FOV: 45 degrees — 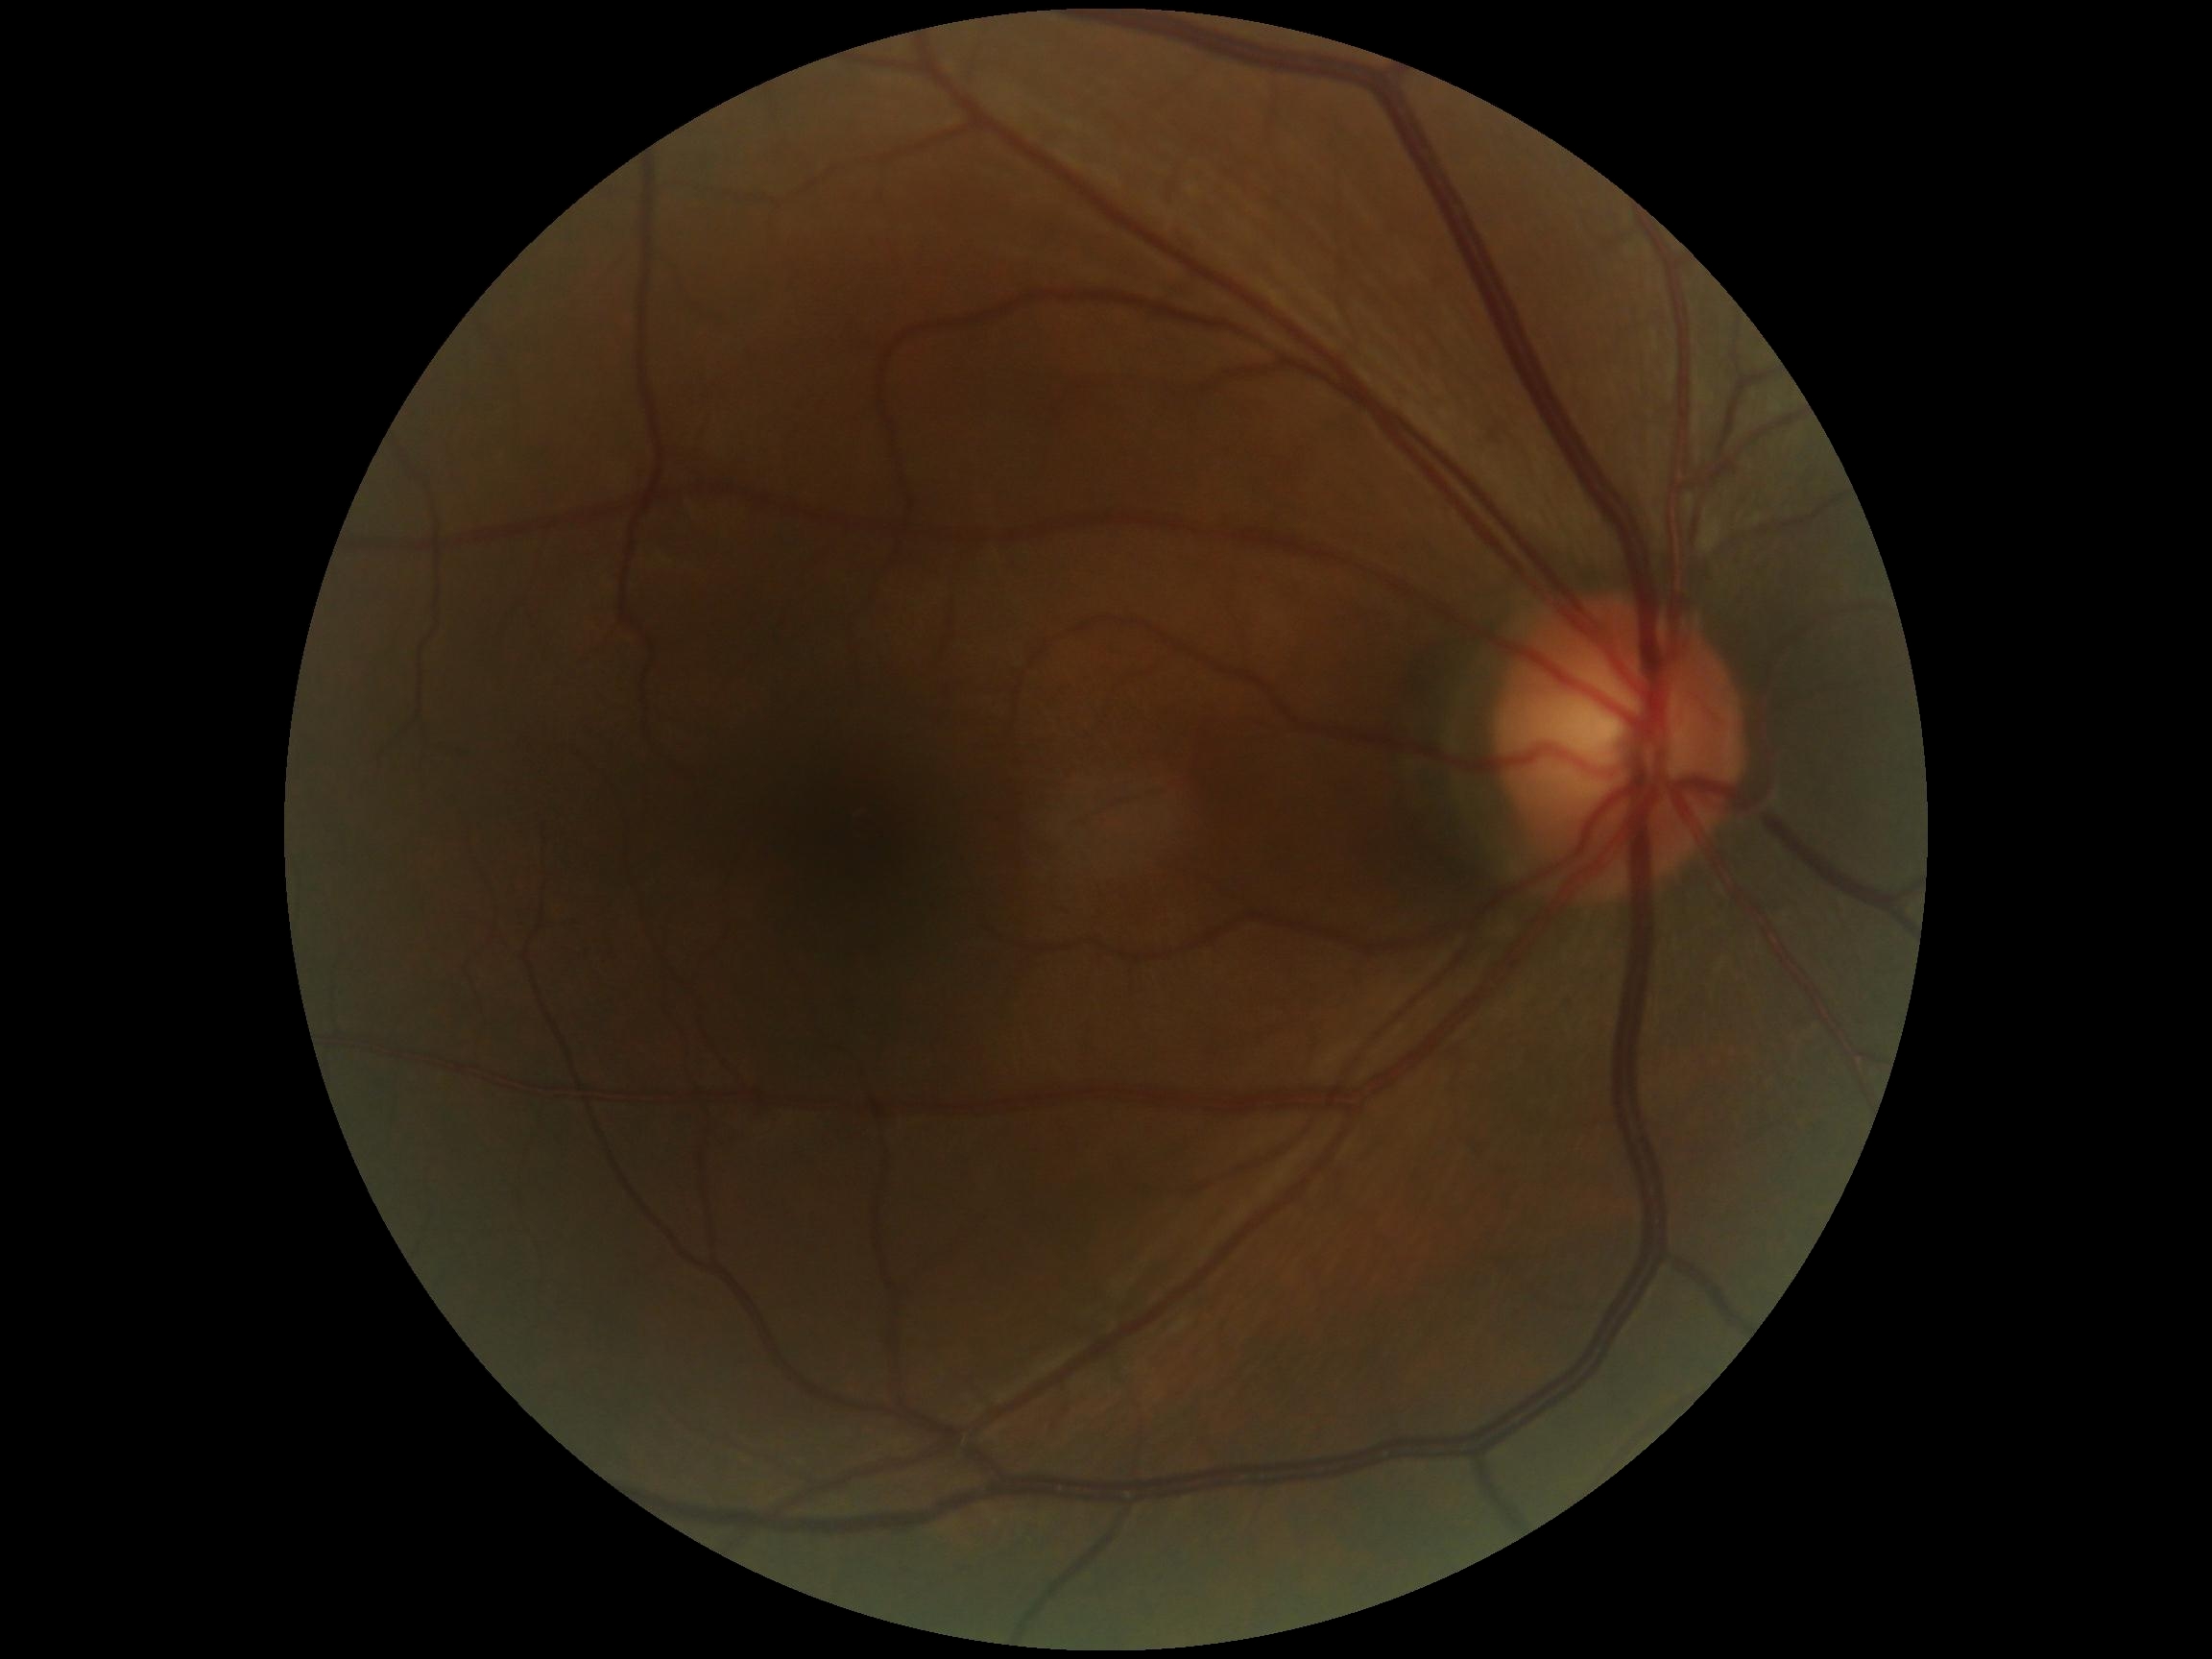
DR grade: 0/4.